Image size 640x480. Pediatric wide-field fundus photograph: 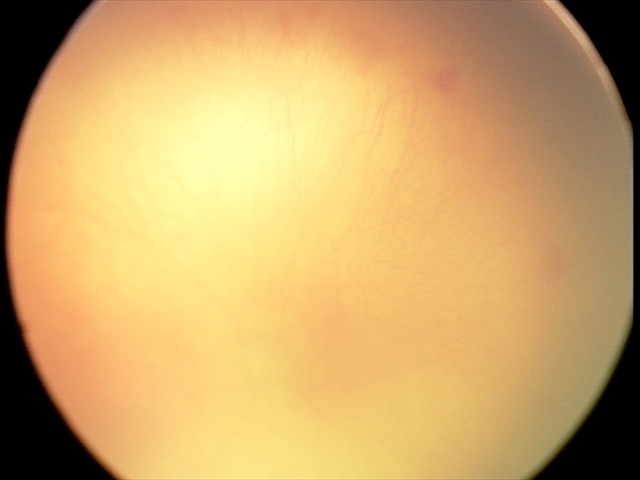 Plus disease: present, screening diagnosis: aggressive retinopathy of prematurity.